NIDEK AFC-230. Color fundus image. 45-degree field of view. Without pupil dilation: 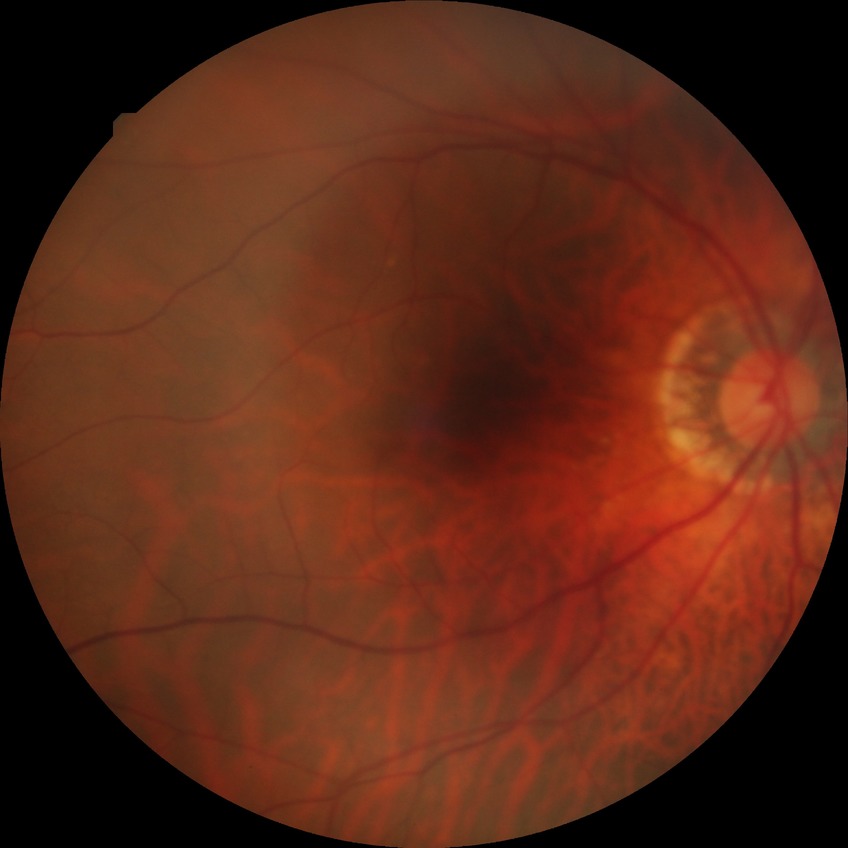 Findings:
- diabetic retinopathy (DR): no diabetic retinopathy (NDR)